2352 by 1568 pixels:
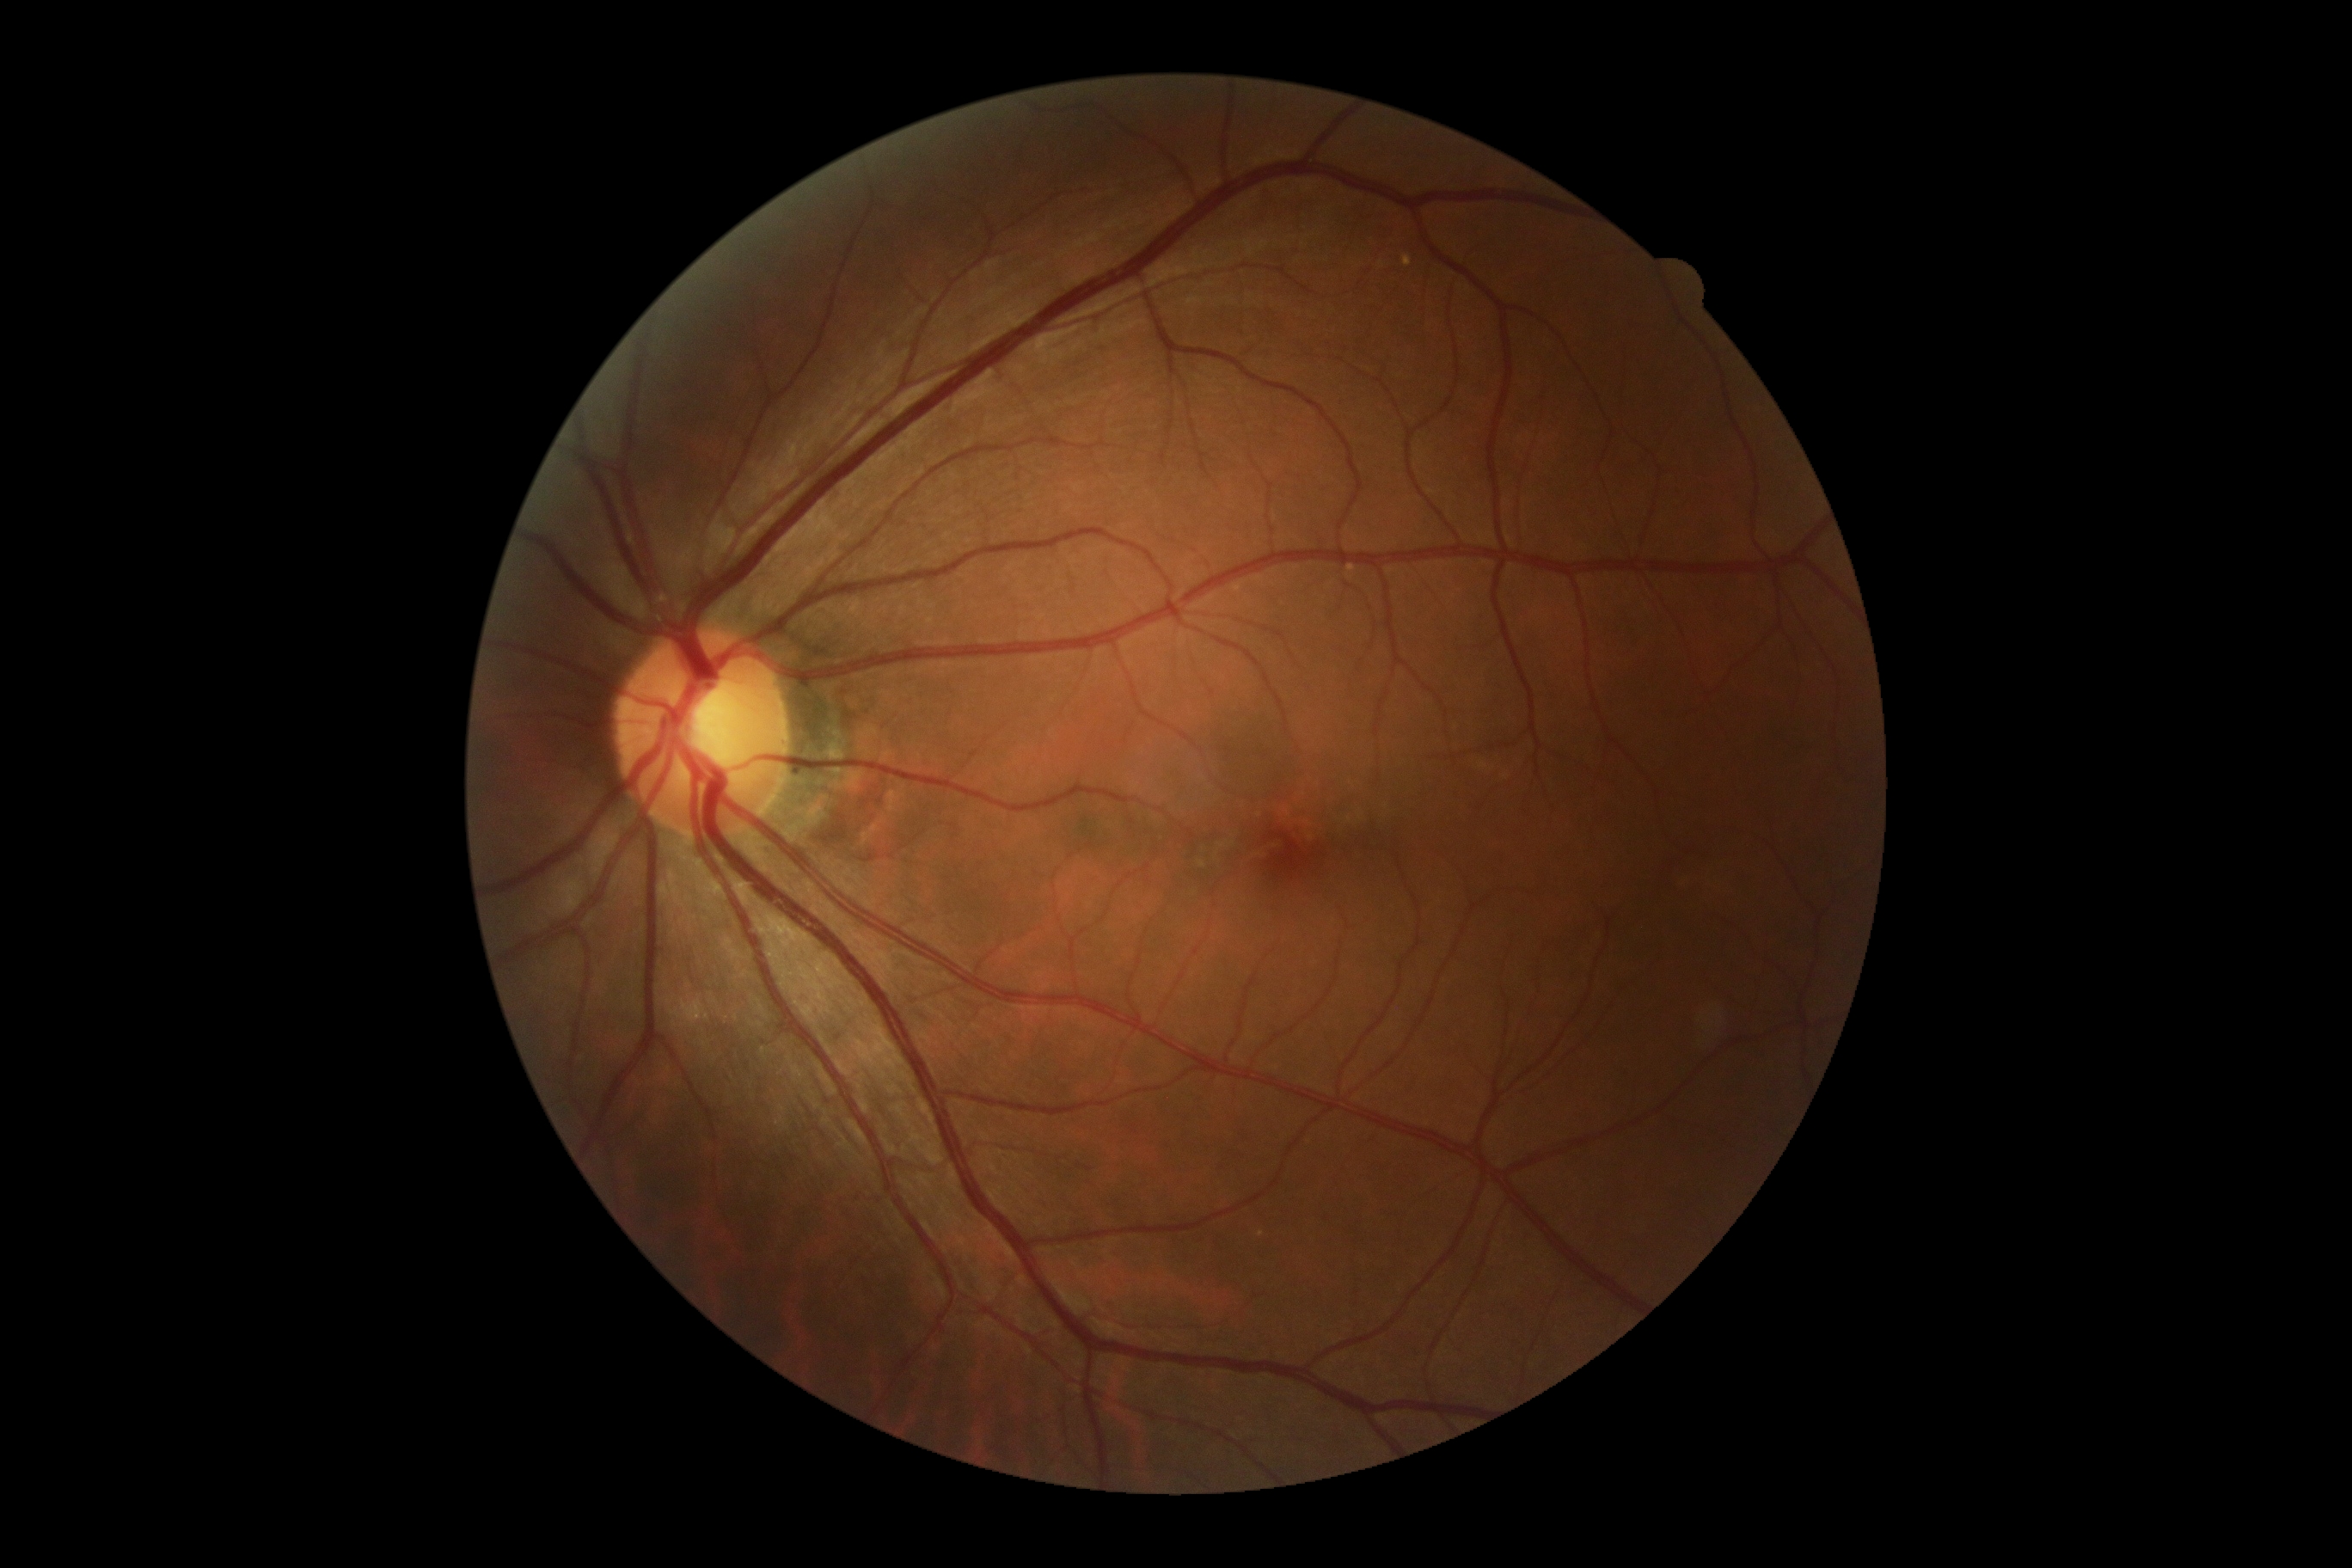

No signs of diabetic retinopathy.
DR severity: no apparent retinopathy (grade 0).